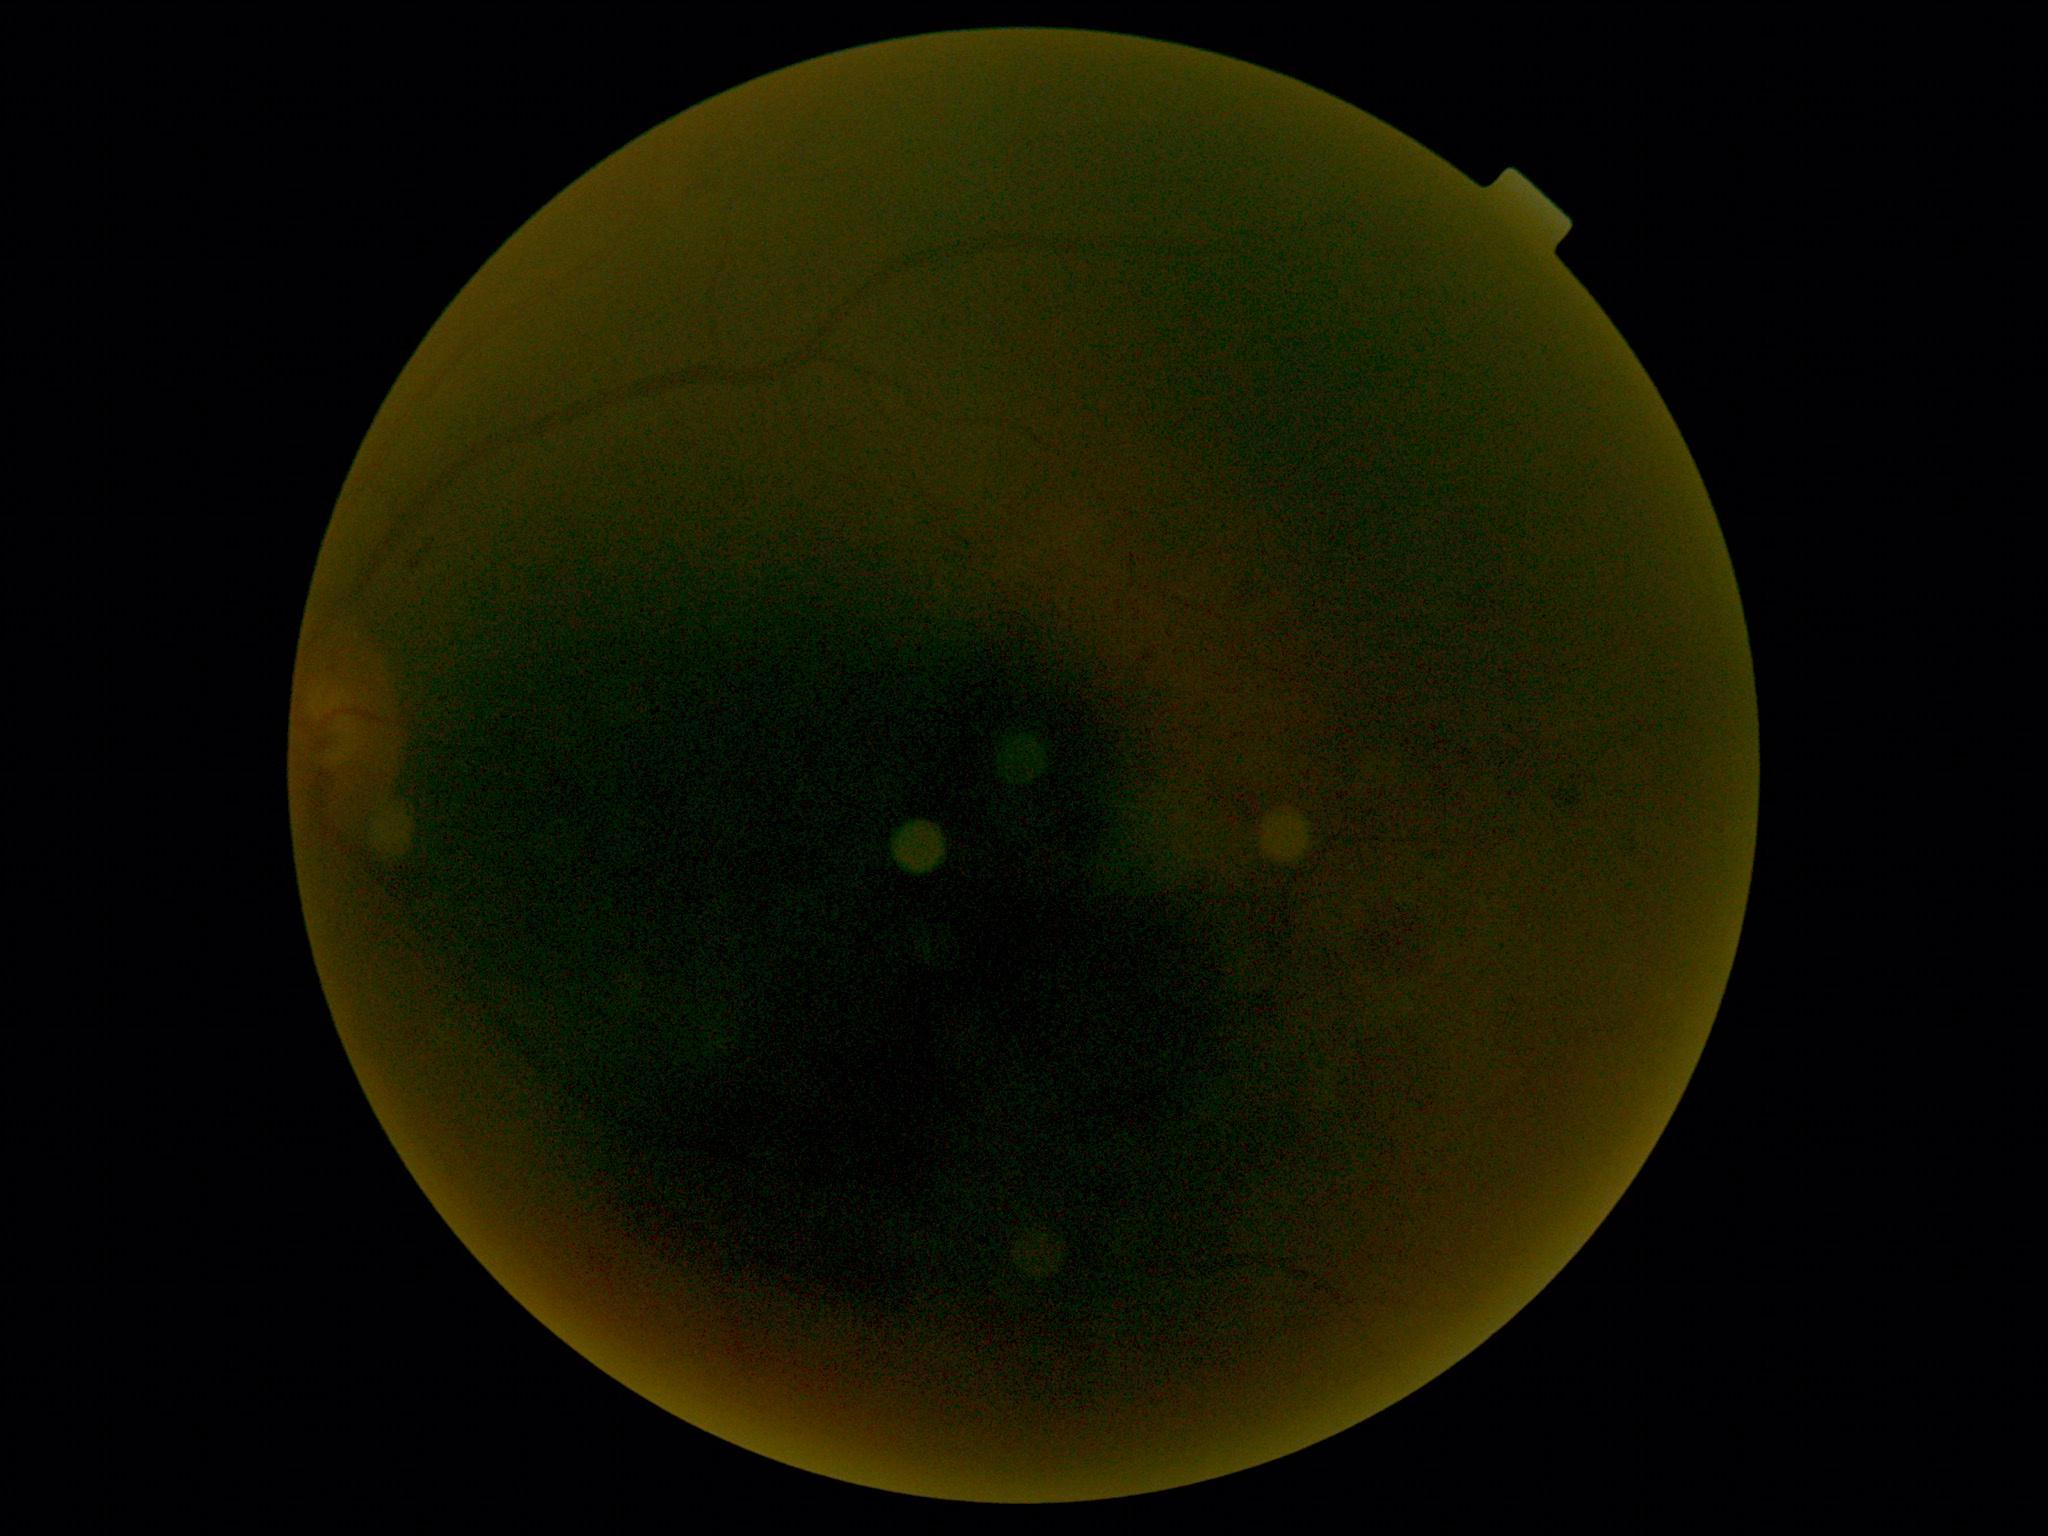
DR stage is ungradable due to poor image quality.